Non-mydriatic acquisition — 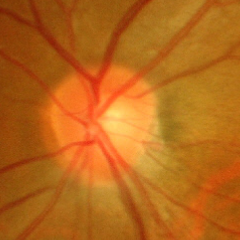

Glaucomatous changes are present. Glaucoma assessment = advanced glaucoma.